Image size 2352x1568, 45° FOV: 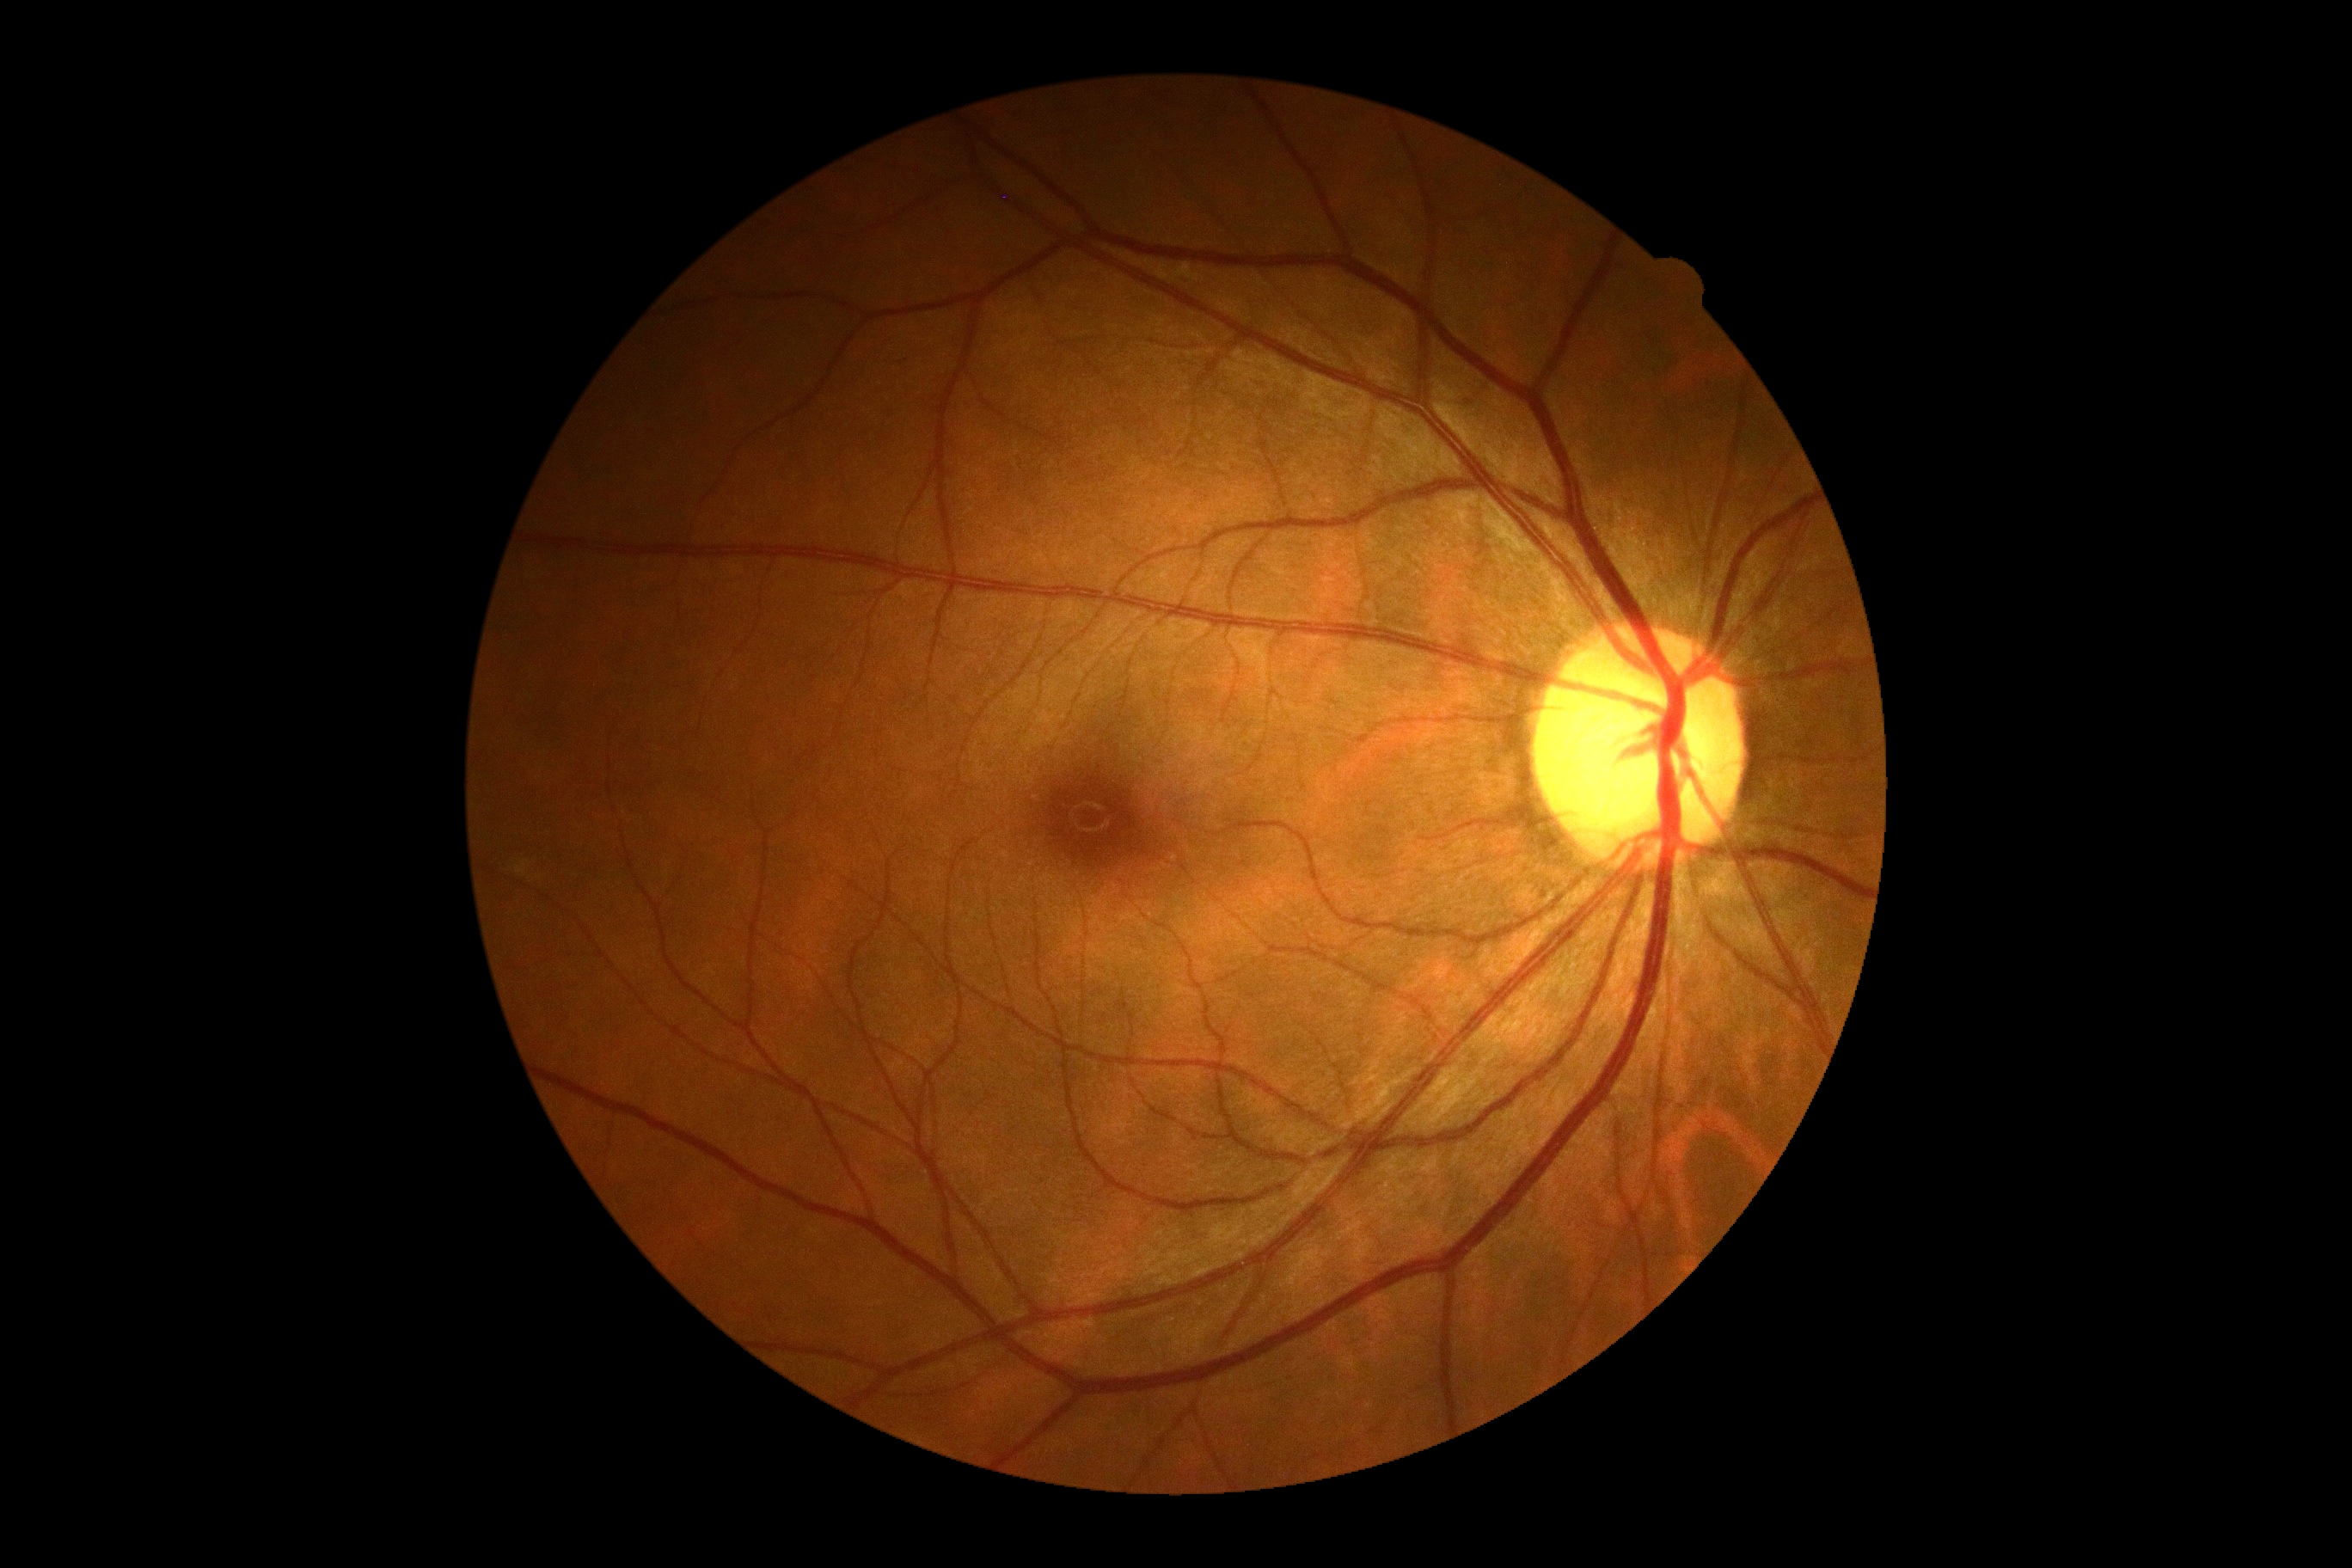

Findings:
• diabetic retinopathy: 0